45-degree field of view, no pharmacologic dilation:
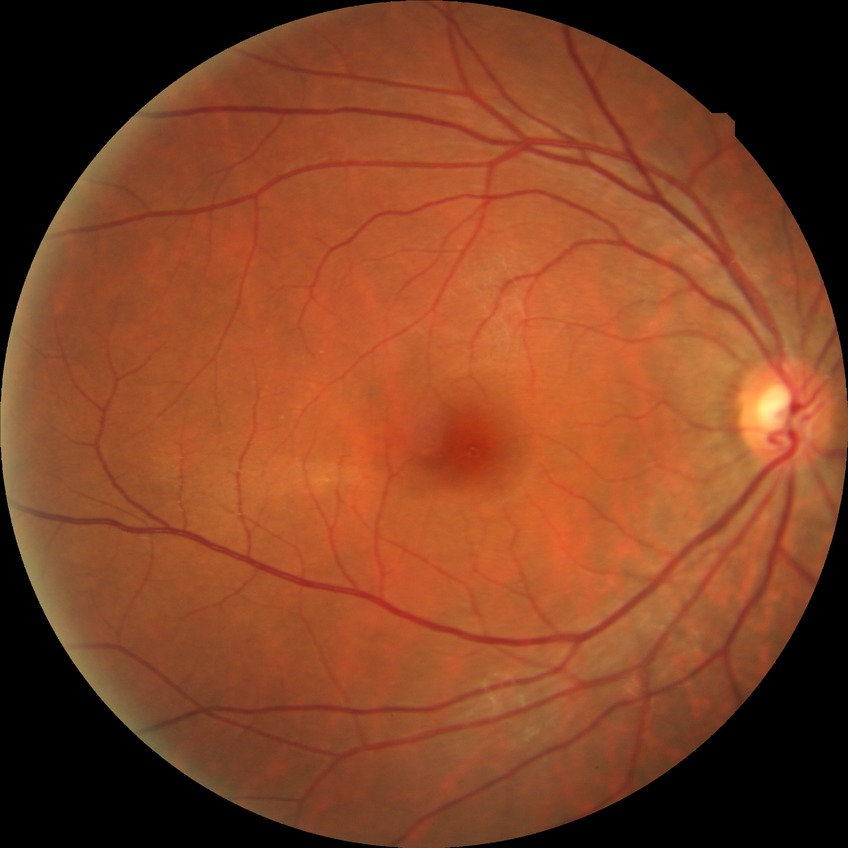

Diabetic retinopathy (DR) is NDR (no diabetic retinopathy).